Infant wide-field fundus photograph · 100° field of view (Phoenix ICON):
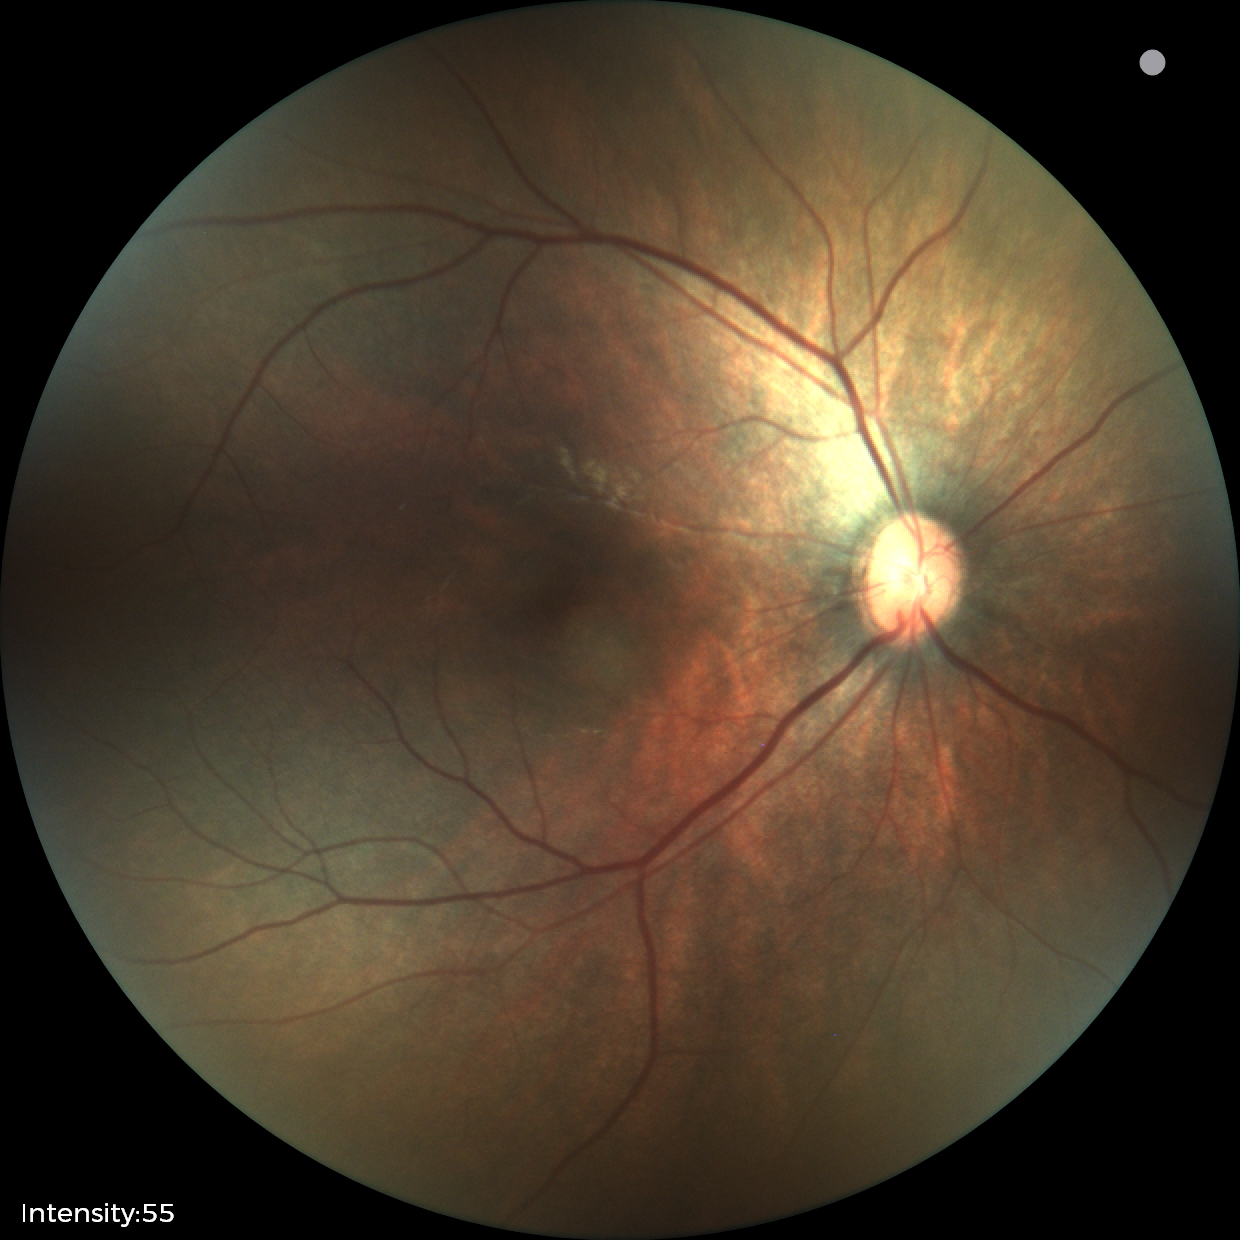

Examination with physiological retinal findings.